640 x 480 pixels · wide-field fundus photograph of an infant
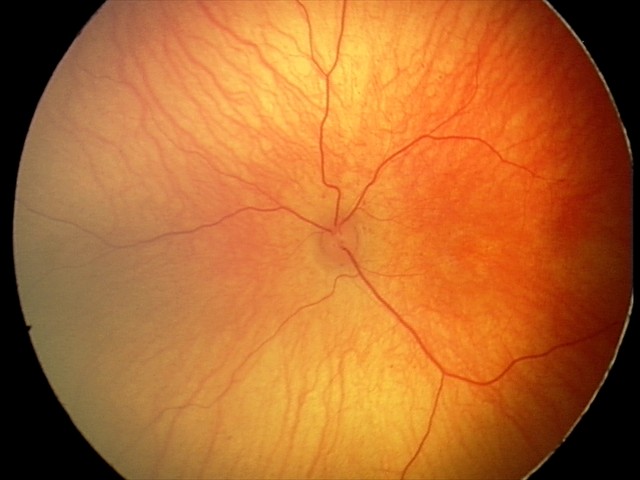
Physiological retinal appearance for postconceptual age.